848 by 848 pixels · retinal fundus photograph · nonmydriatic fundus photograph · graded on the modified Davis scale · FOV: 45 degrees · NIDEK AFC-230: 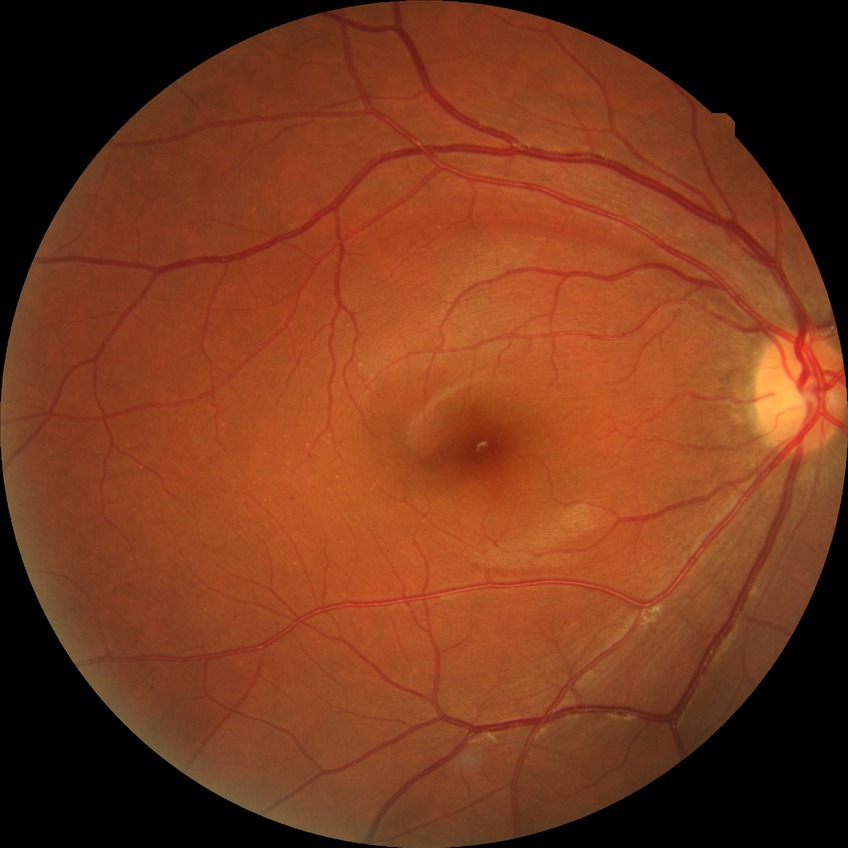

diabetic retinopathy stage = simple diabetic retinopathy.